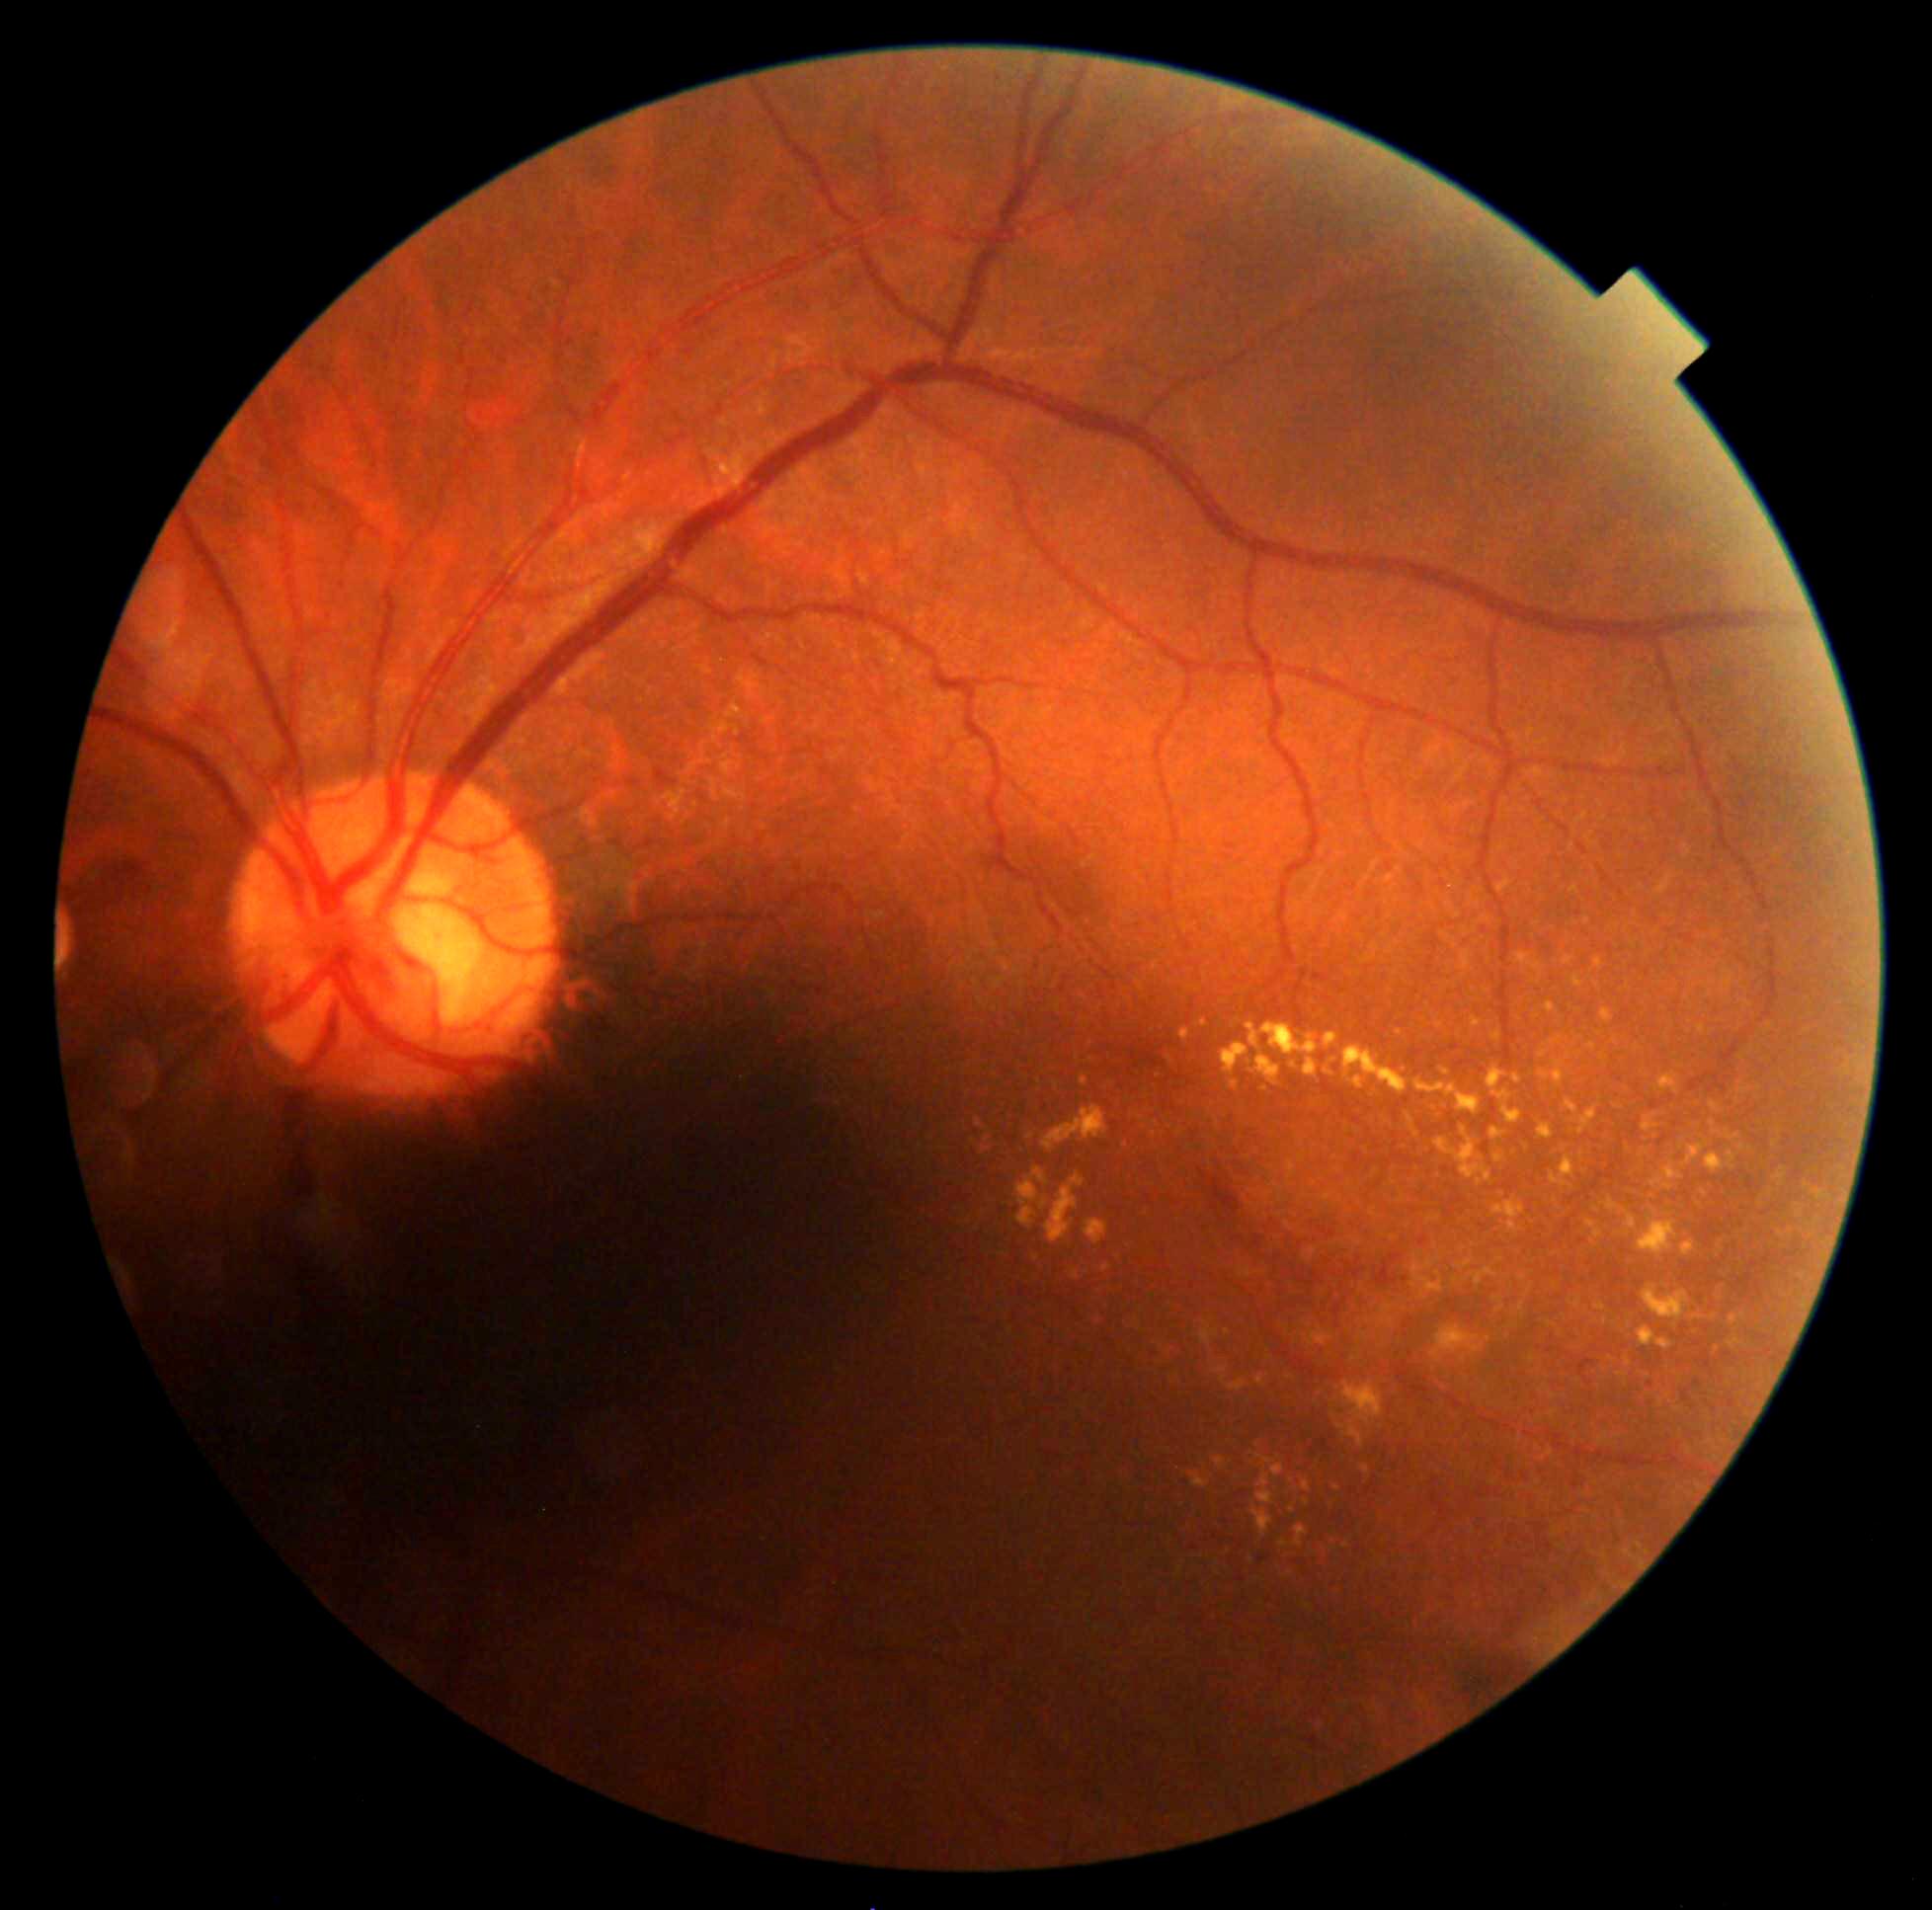

Diabetic retinopathy (DR) is 2/4
Lesions identified (partial list):
* hard exudates (EXs) (subset): 1564, 956, 1575, 965; 1624, 1211, 1637, 1231; 1570, 886, 1579, 894; 1577, 1107, 1599, 1136; 1586, 1220, 1603, 1239; 1289, 1062, 1298, 1071; 1343, 1046, 1409, 1096; 1027, 1134, 1035, 1141; 1711, 1101, 1721, 1114; 1343, 1381, 1384, 1427; 1538, 1062, 1566, 1089; 1601, 1010, 1614, 1024
* Additional small EXs near <point>1169, 1060</point>; <point>1714, 1317</point>; <point>1780, 1132</point>; <point>987, 1141</point>; <point>1489, 1340</point>; <point>1579, 1011</point>; <point>1743, 1148</point>